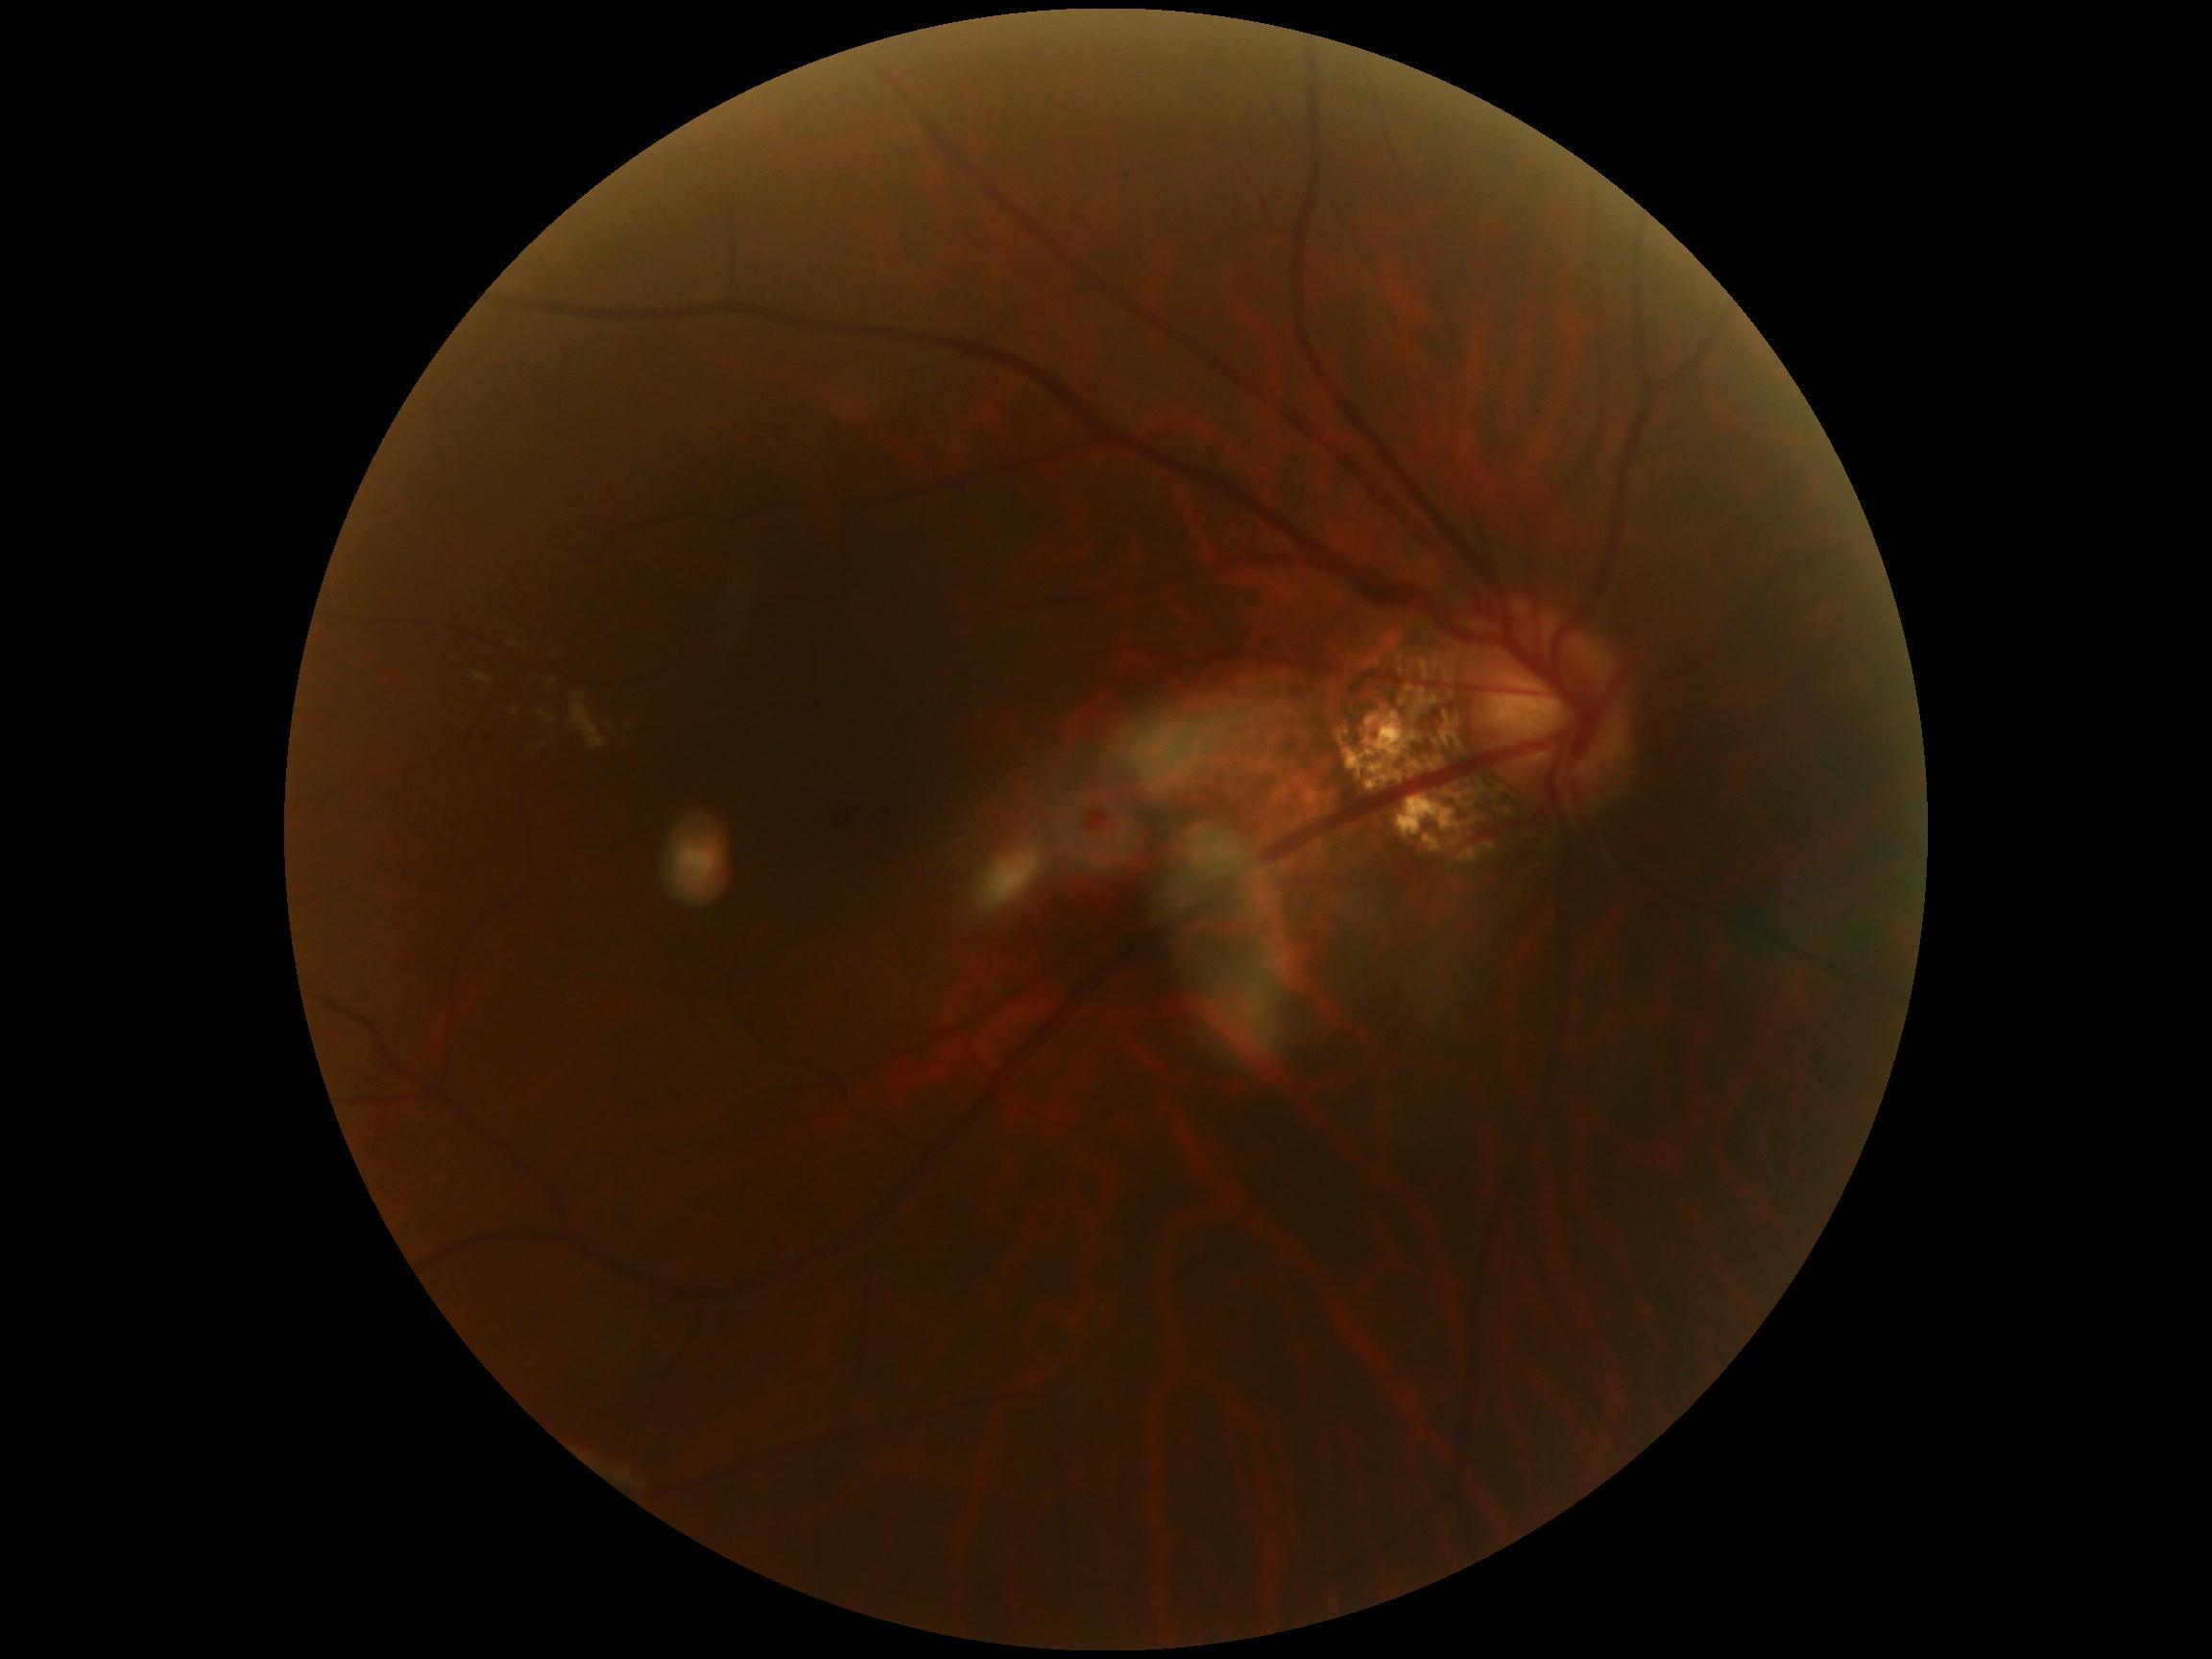

DR@moderate non-proliferative diabetic retinopathy (grade 2).